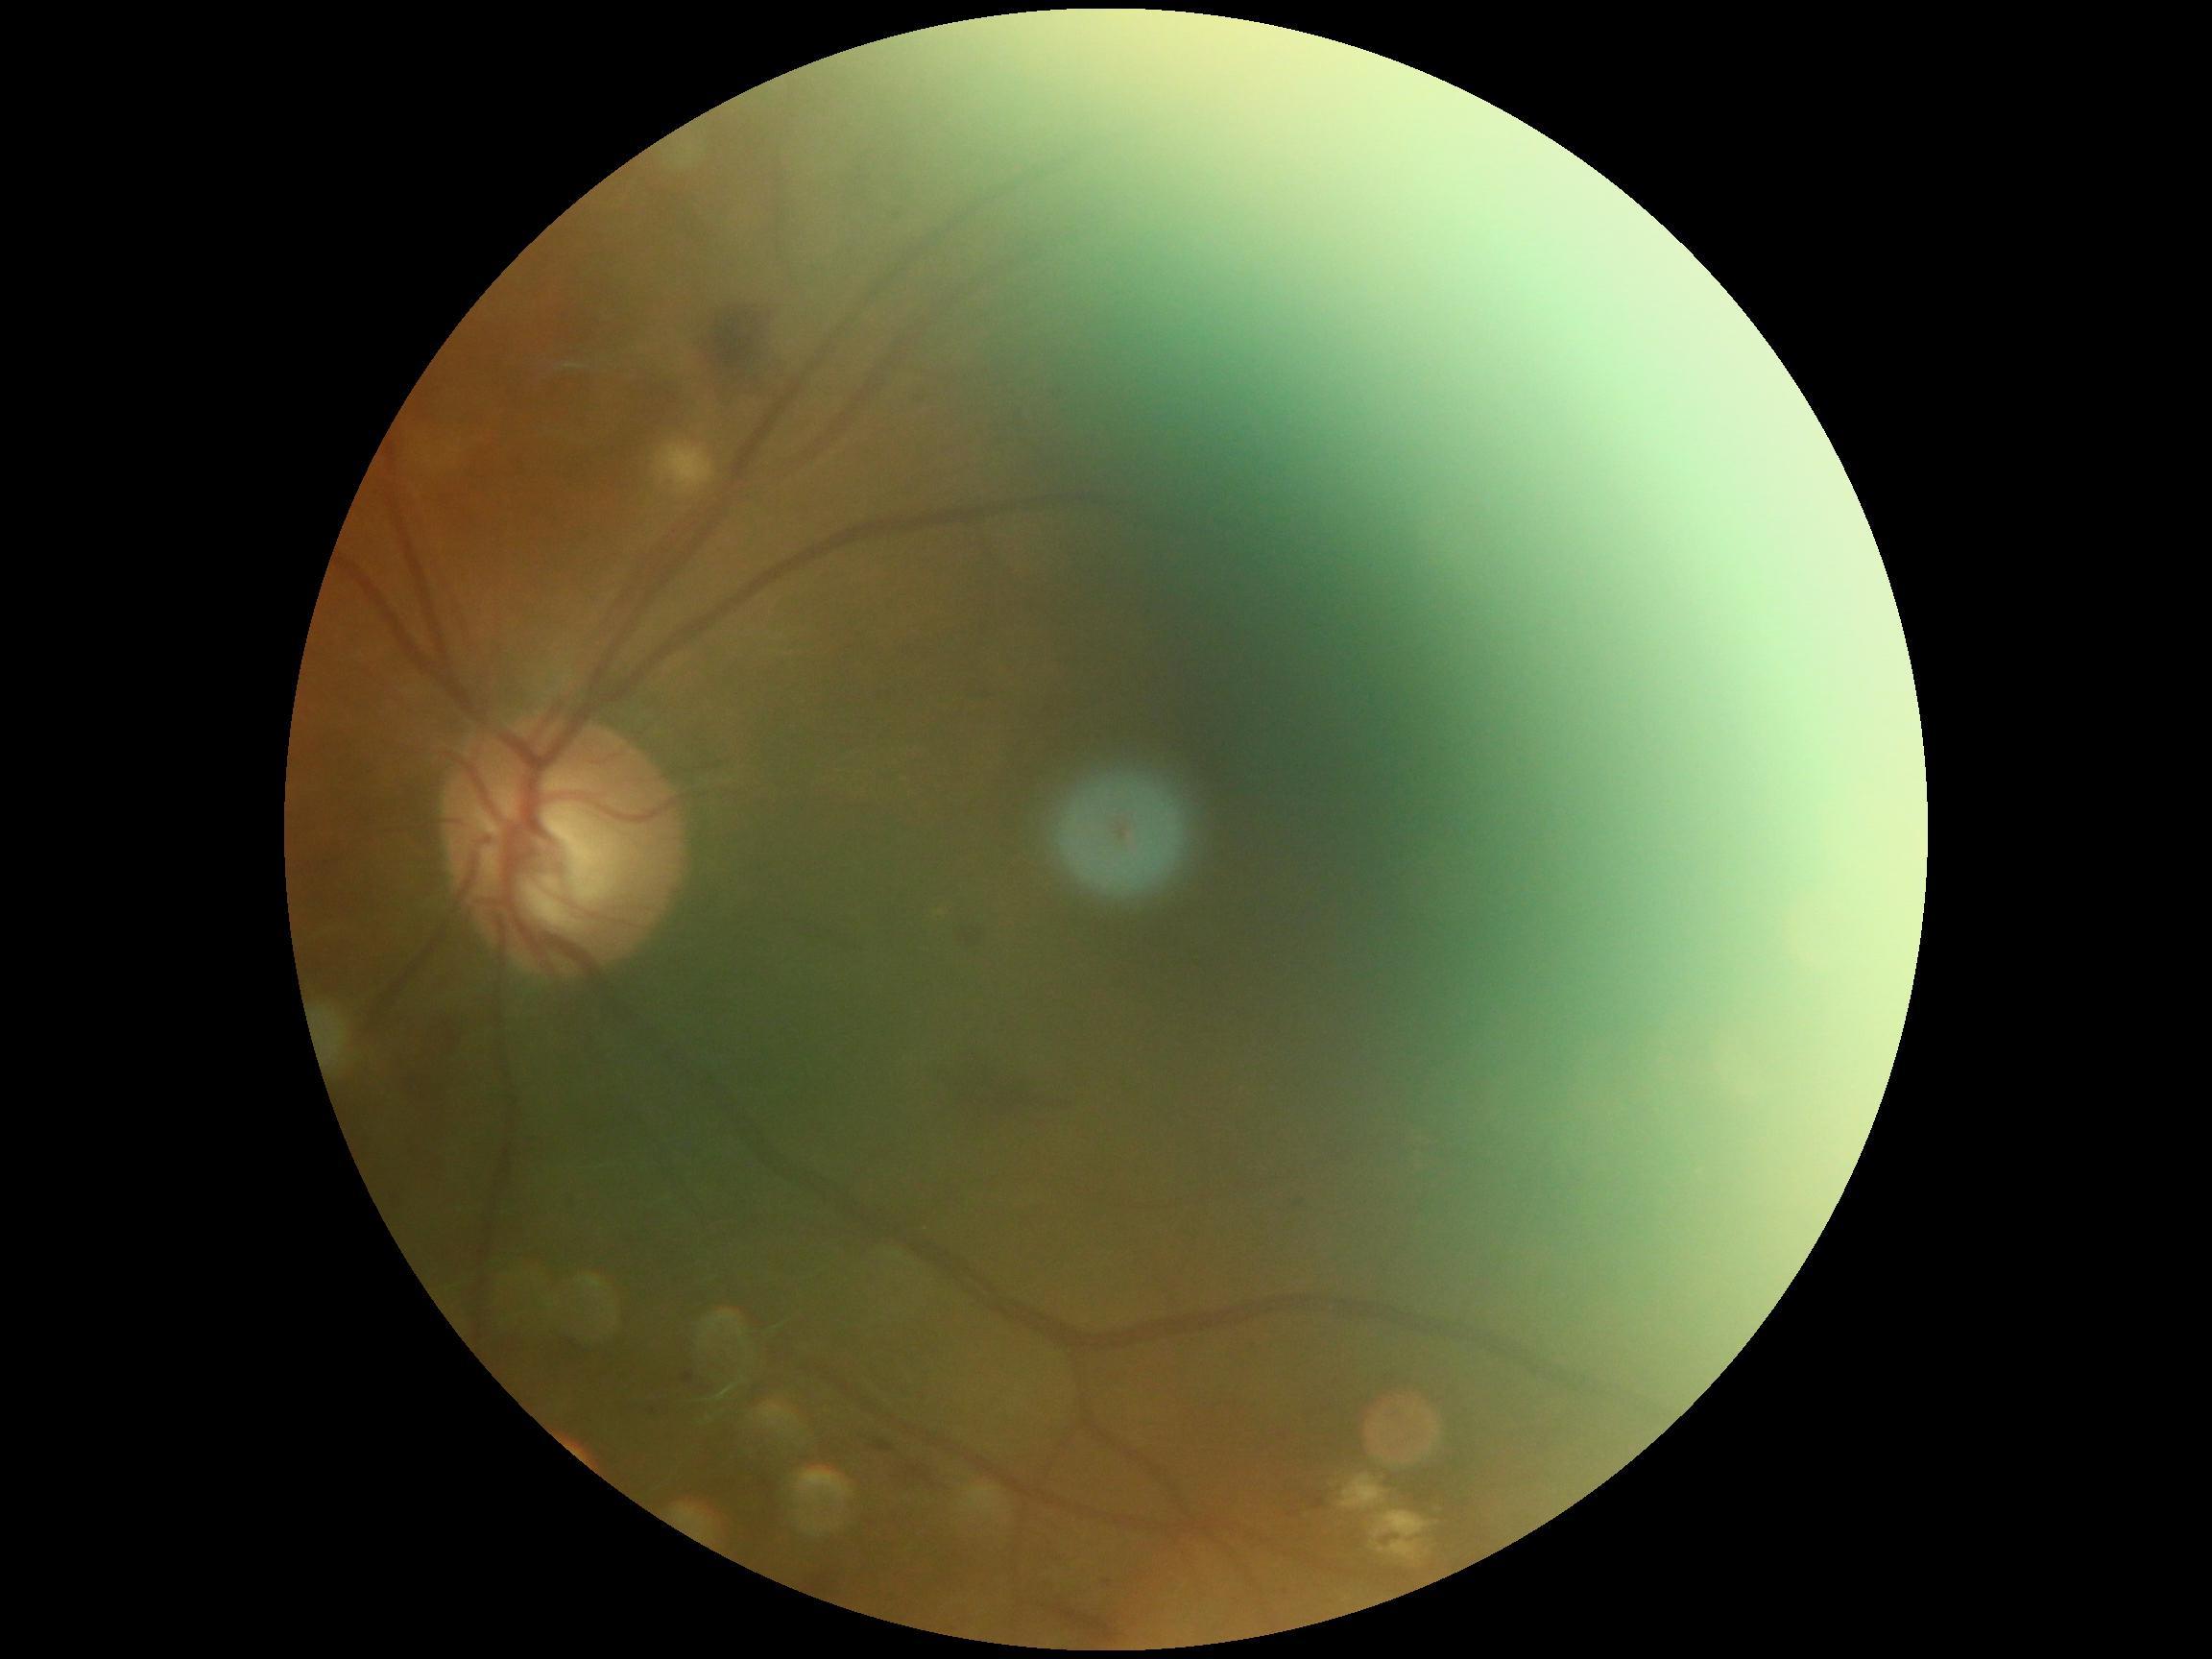

DR grade = moderate NPDR (2); DR class = non-proliferative diabetic retinopathy.